2048 x 1536 pixels
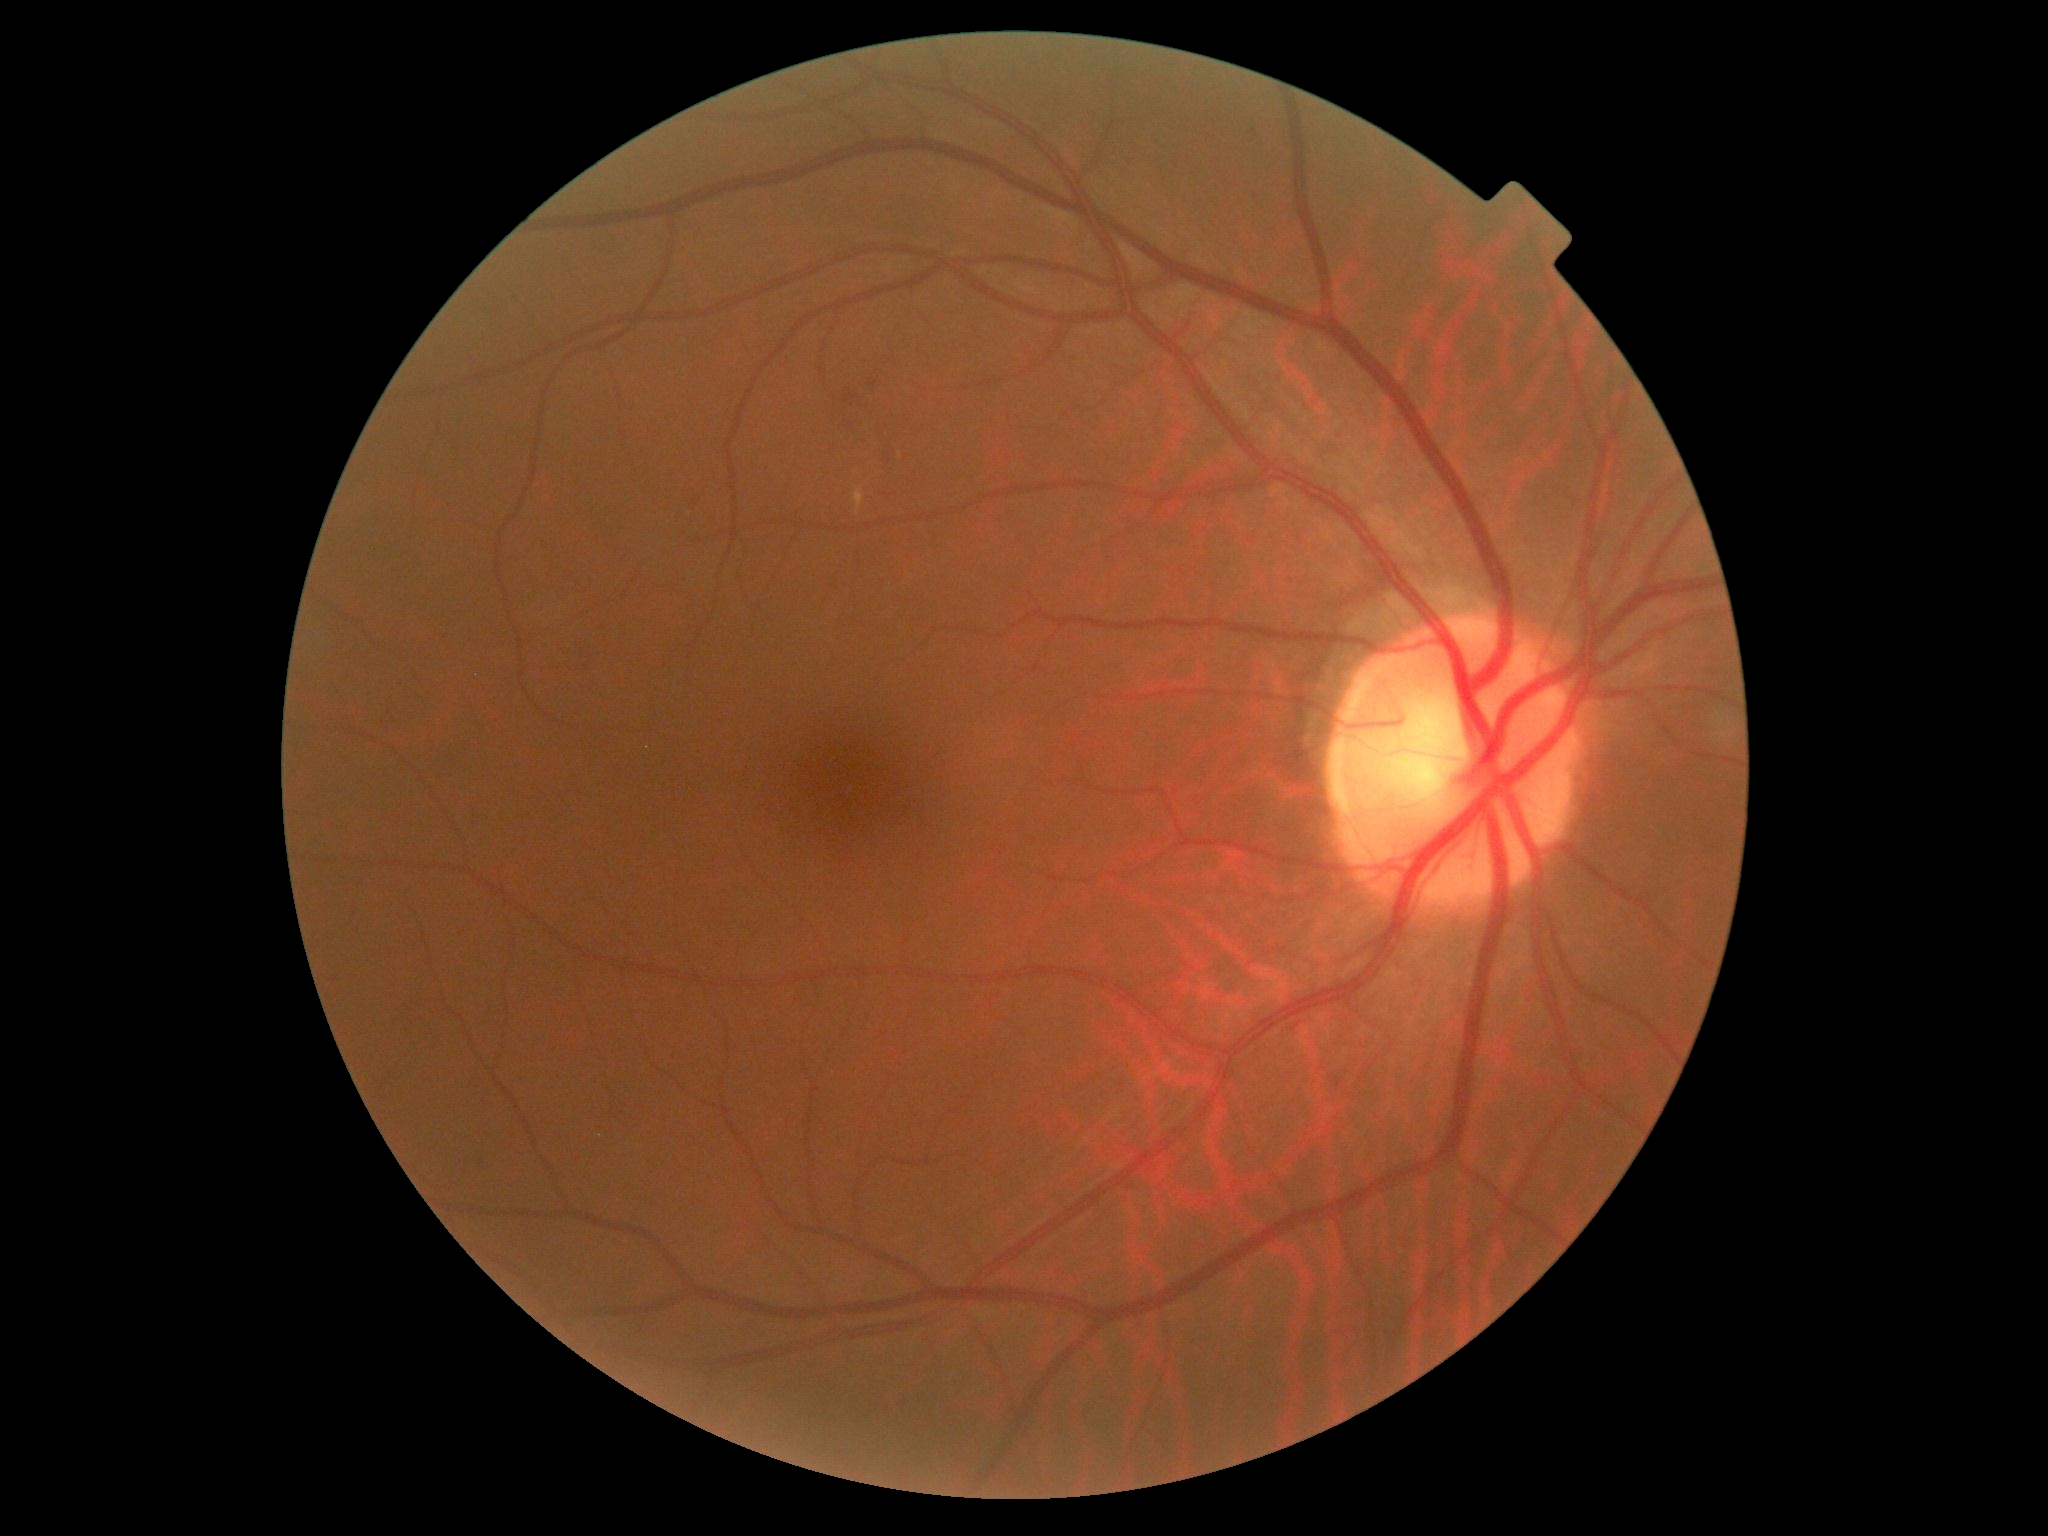
retinopathy grade@moderate NPDR (2).